848x848. CFP:
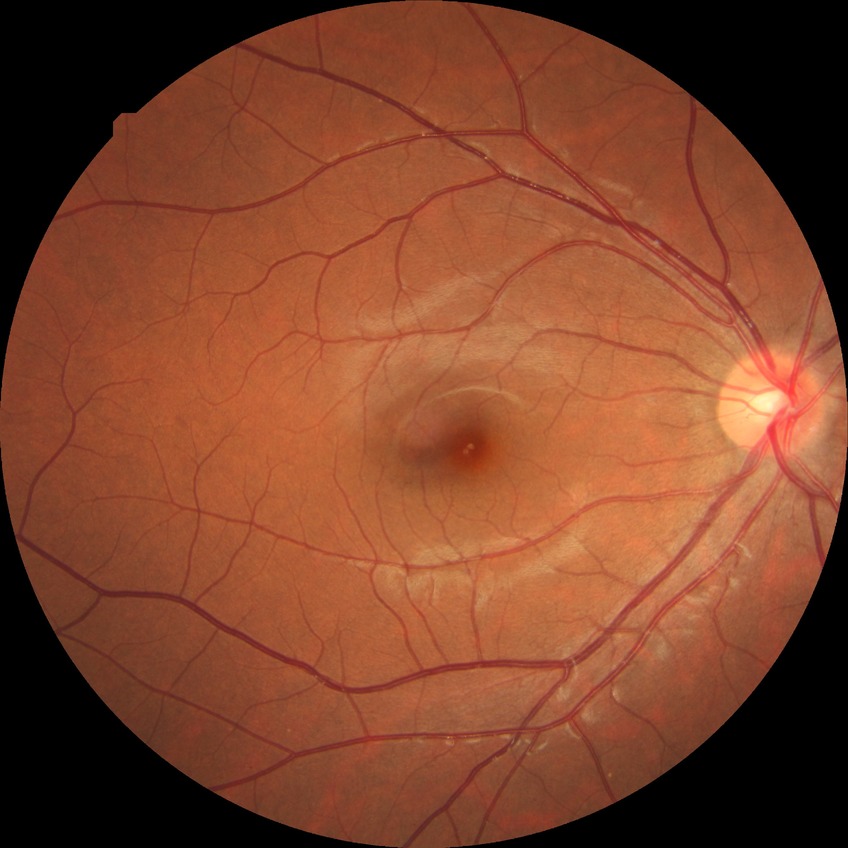 Diabetic retinopathy (DR) is NDR (no diabetic retinopathy).